Nonmydriatic fundus photograph.
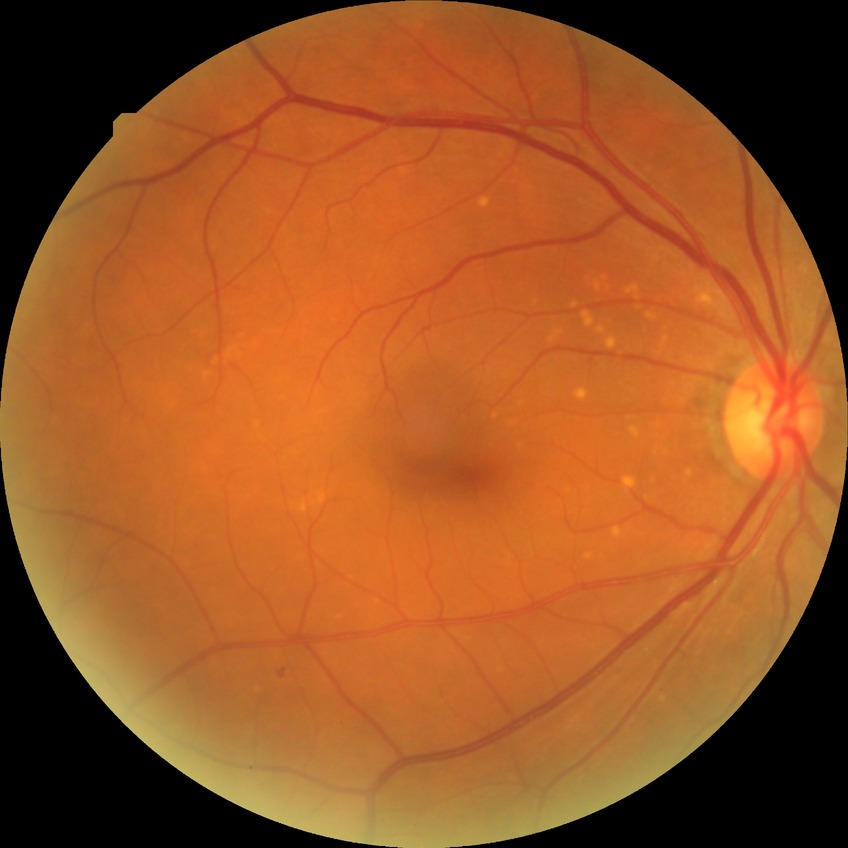
DR severity: SDR.